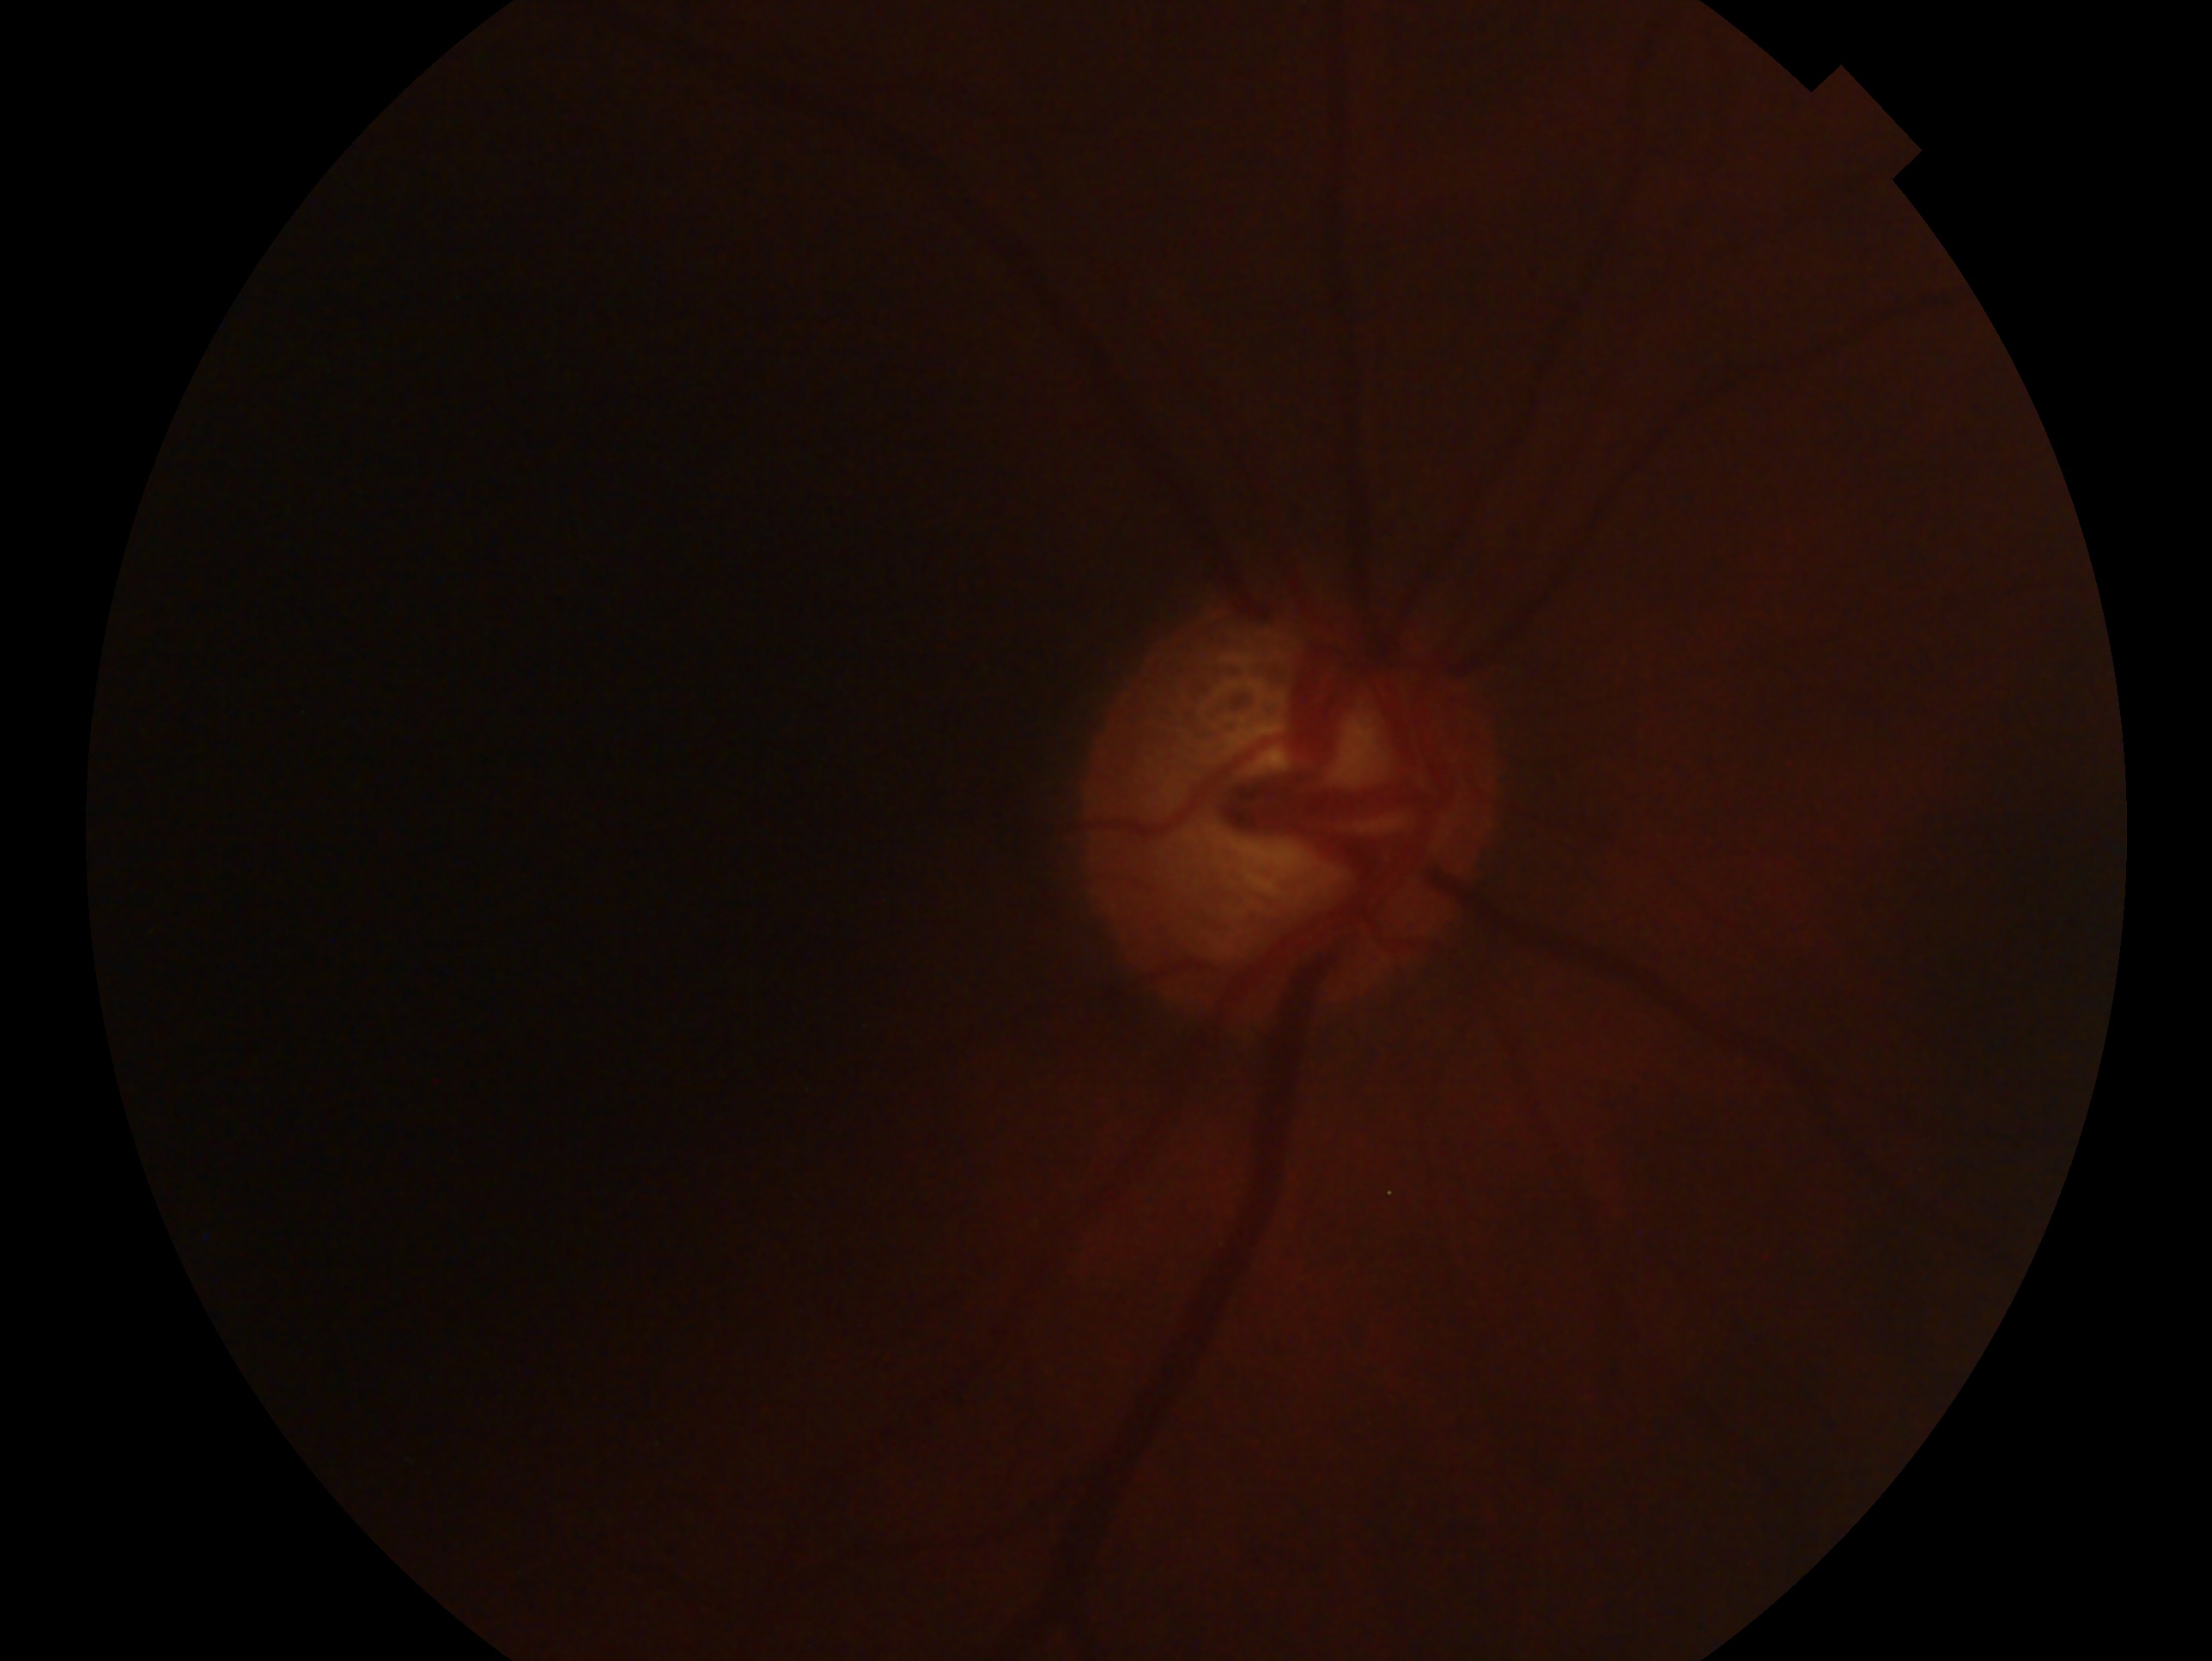 Impression: glaucomatous optic neuropathy. This is the OD.